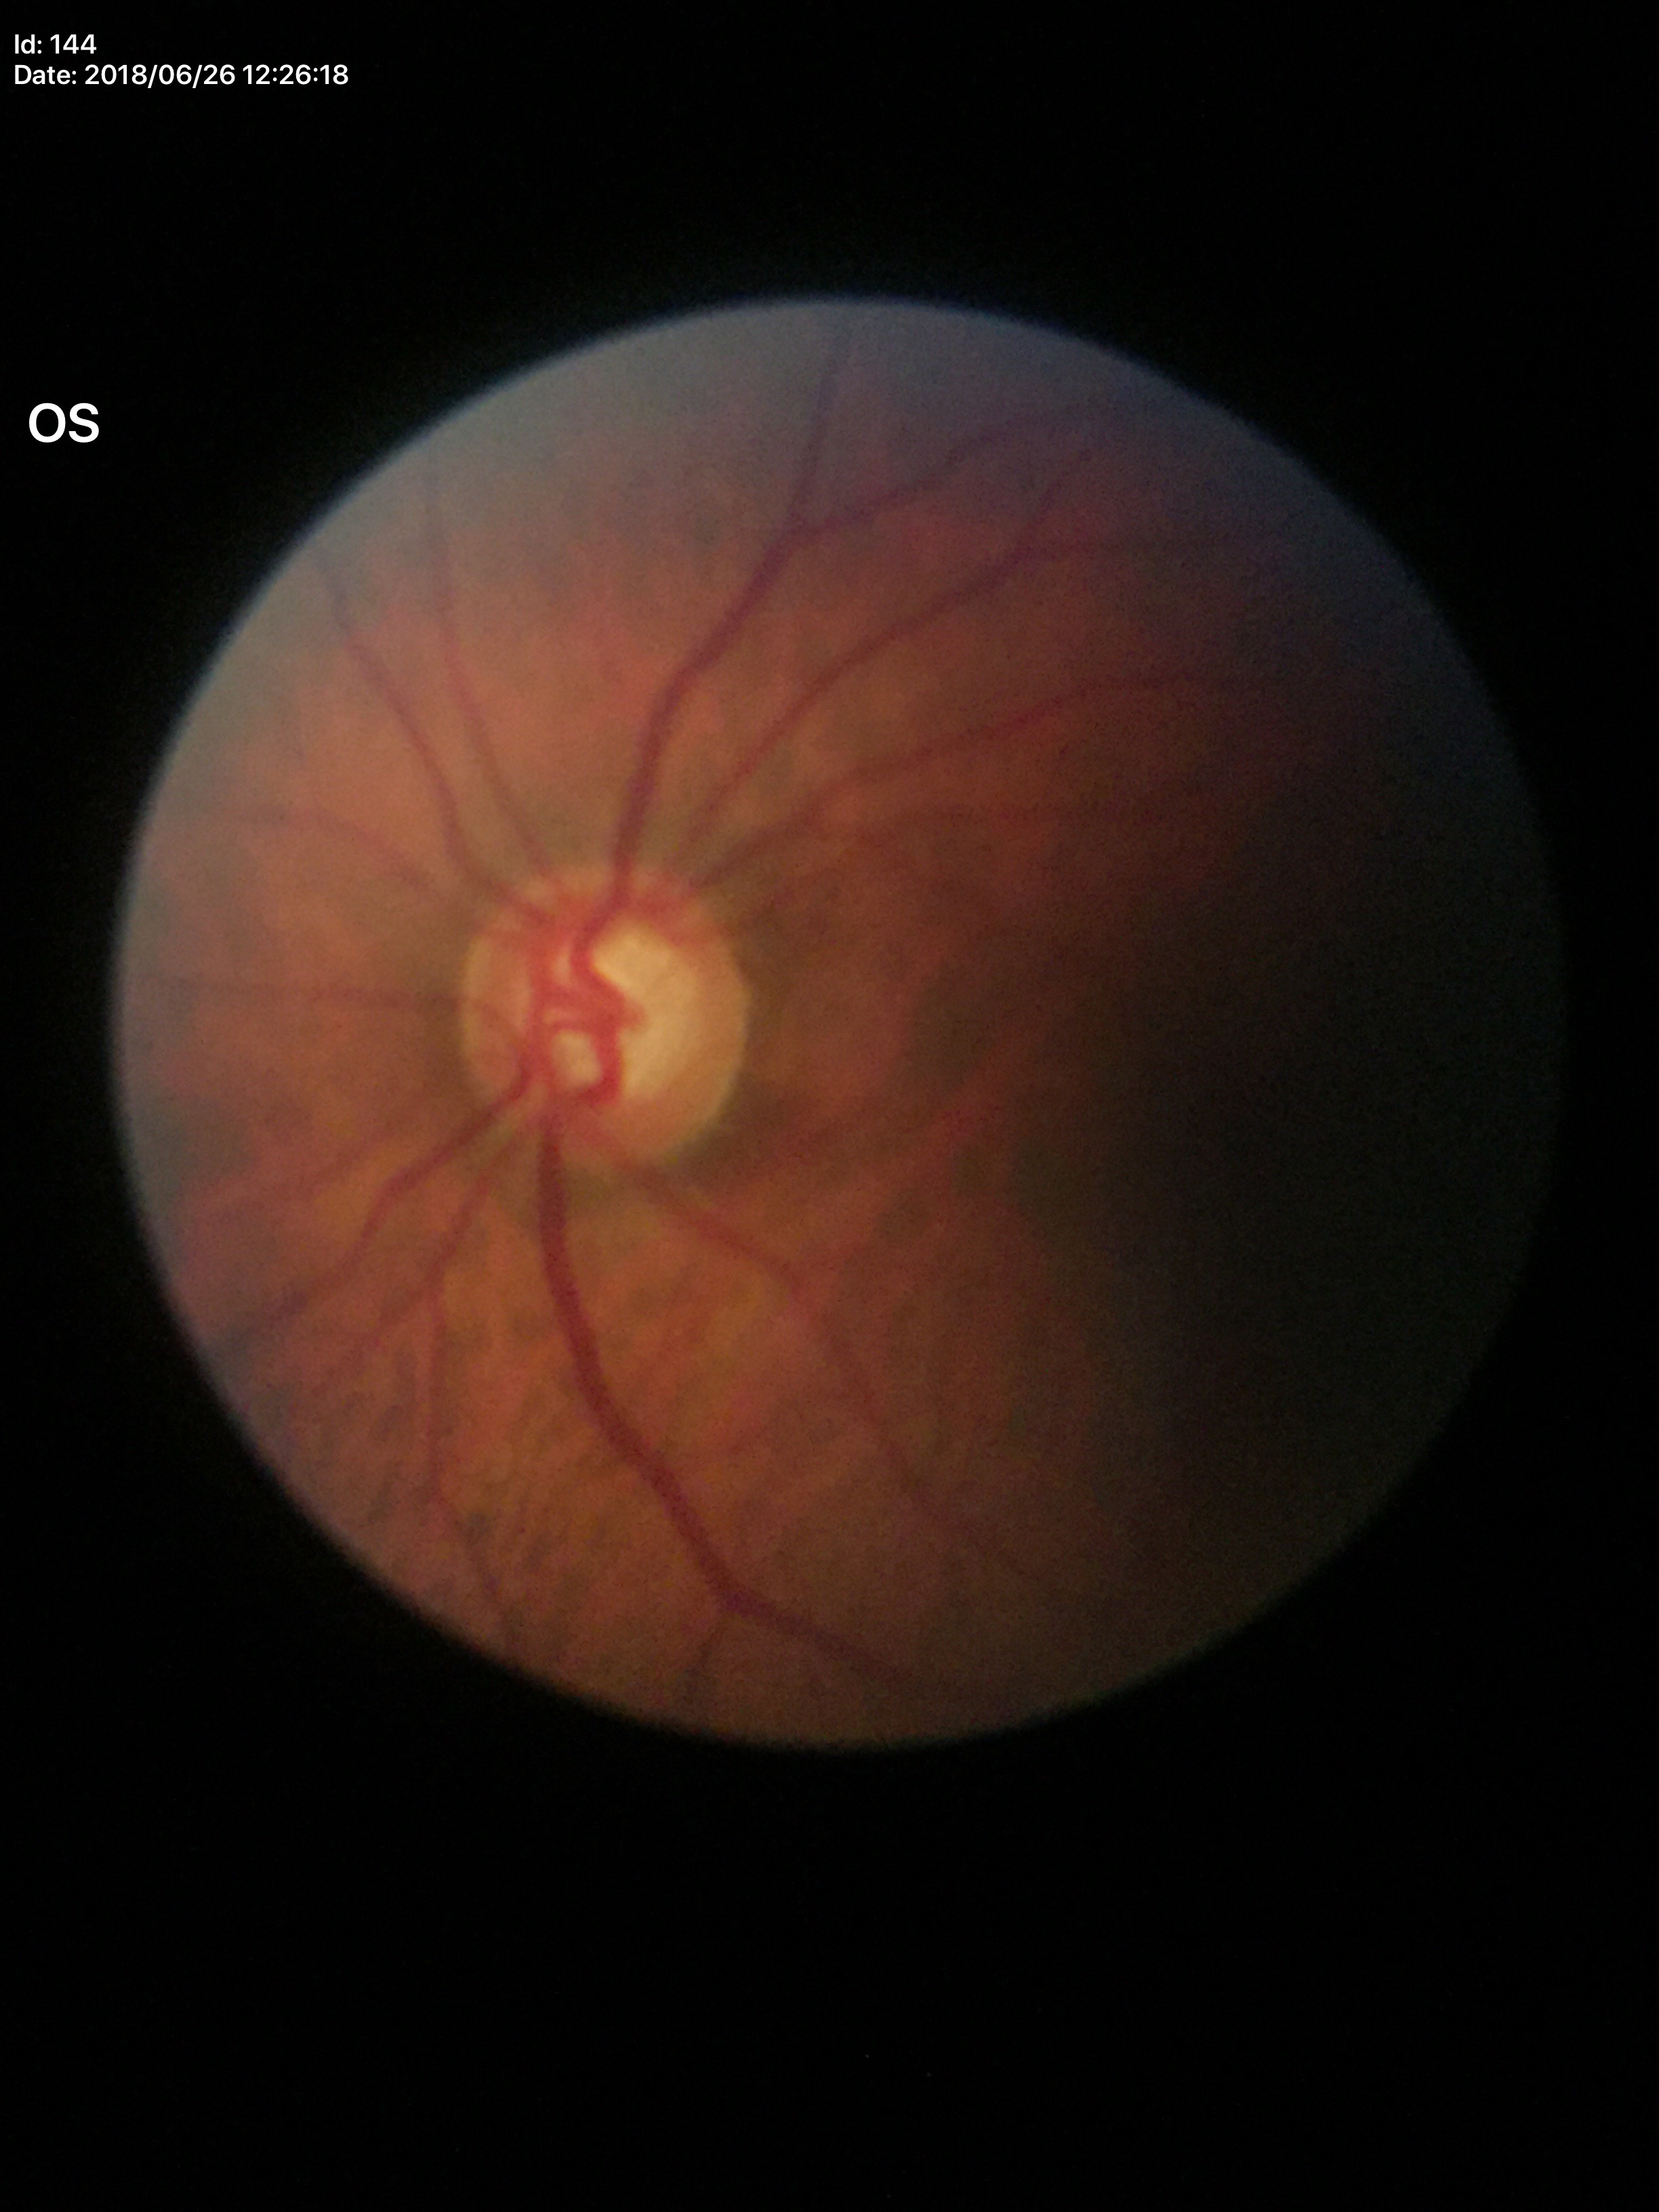
Glaucoma suspect (all 5 graders flagged glaucoma suspect).
Vertical CDR: 0.68.